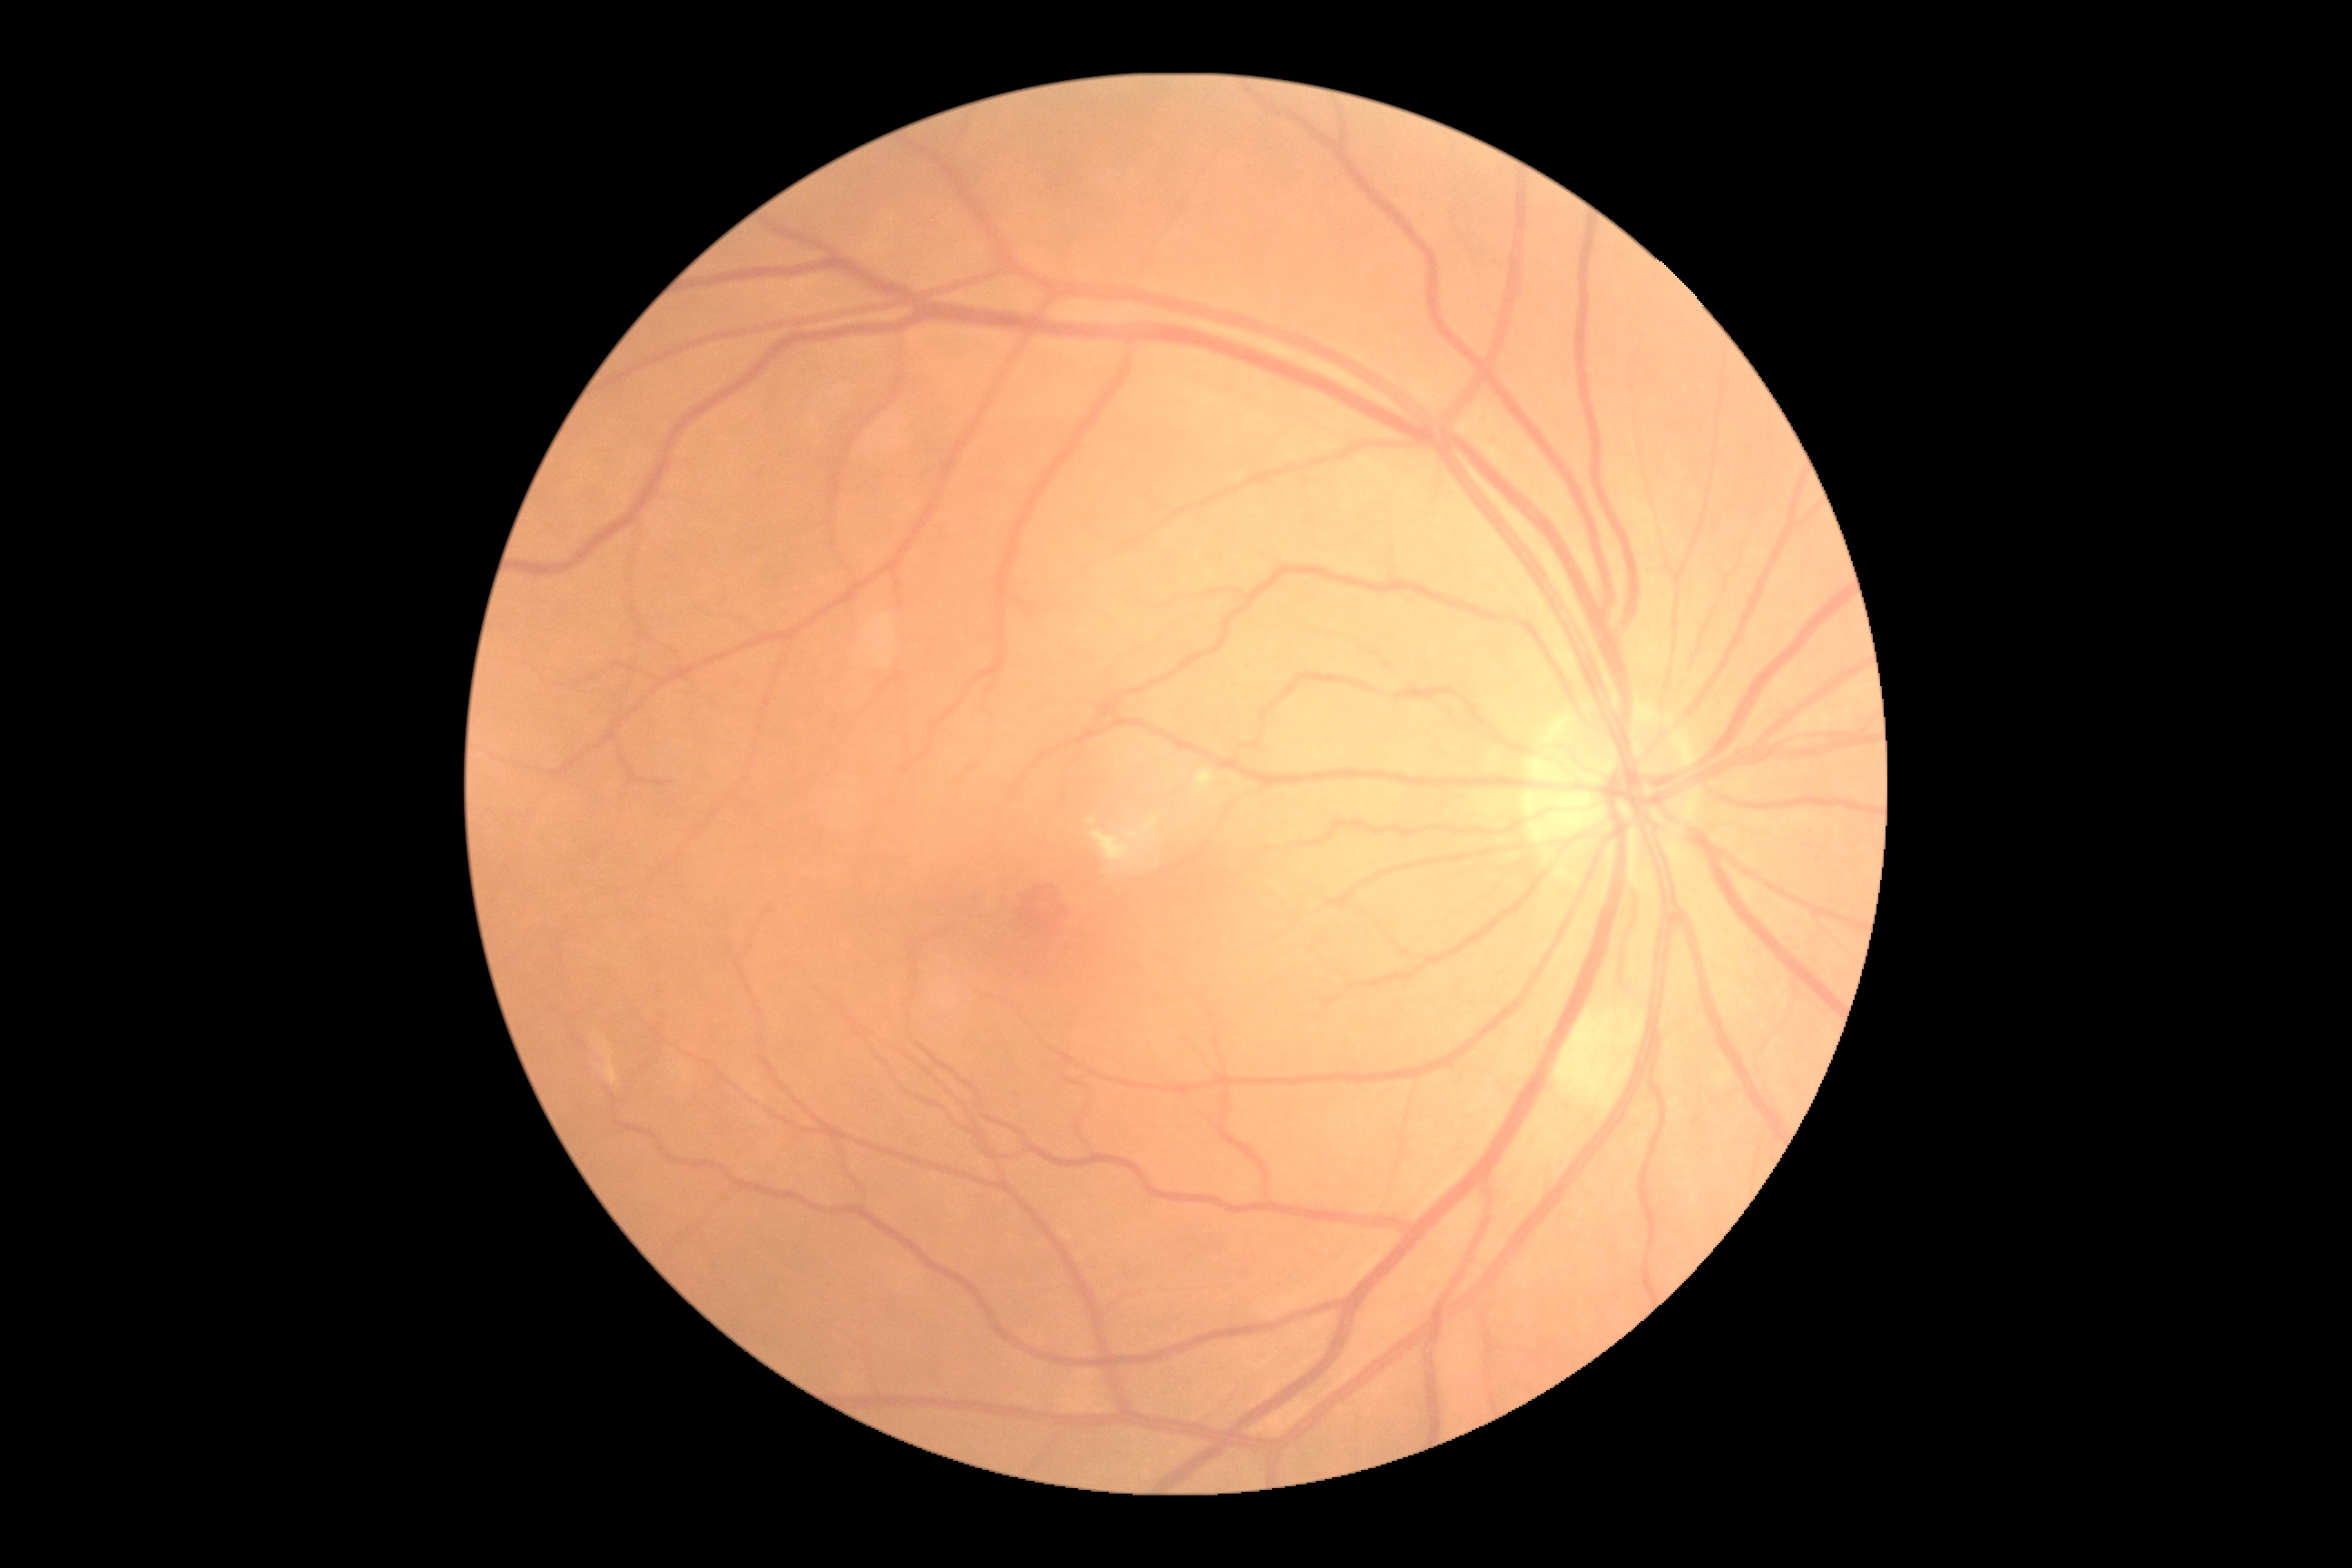 dr_grade: 2
dr_grade_name: moderate NPDR
lesions:
  ex:
    - (left=1195, top=770, right=1215, bottom=792)
    - (left=1090, top=816, right=1161, bottom=865)
    - (left=1086, top=818, right=1095, bottom=825)
  ex_small_approx:
    - x=1113 y=870
  ma: []
  se:
    - (left=1556, top=1008, right=1645, bottom=1113)
  he: []